200° field of view, ultra-widefield fundus photograph
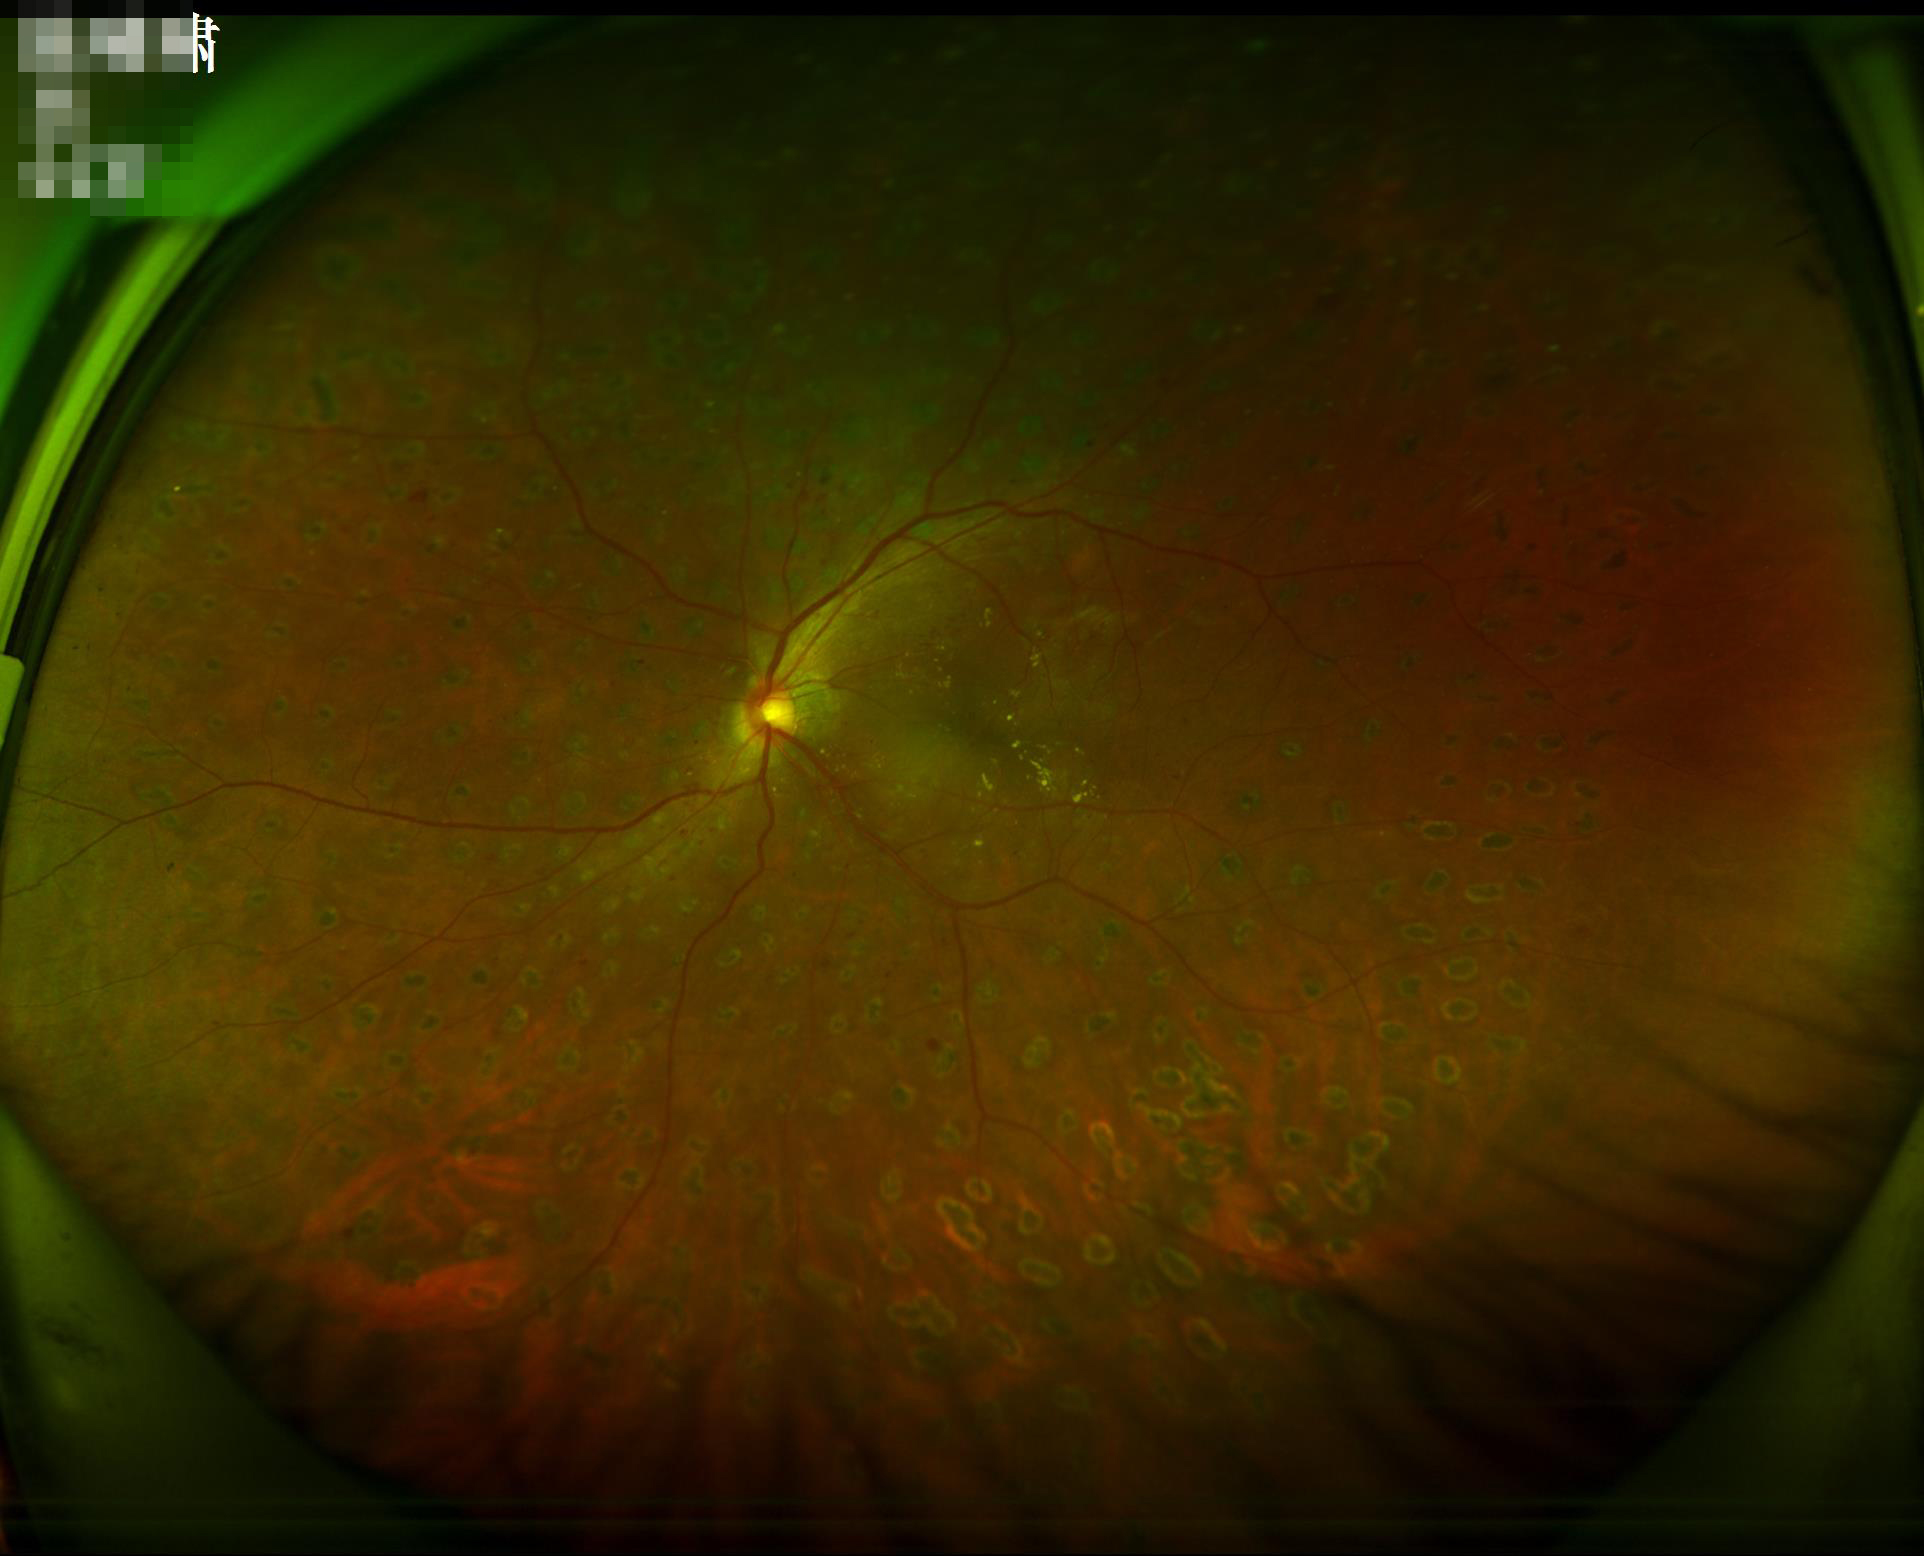
No over- or under-exposure. Vessels and details are readily distinguishable. No noticeable blur. Acceptable image quality.